2352x1568; 45° field of view — 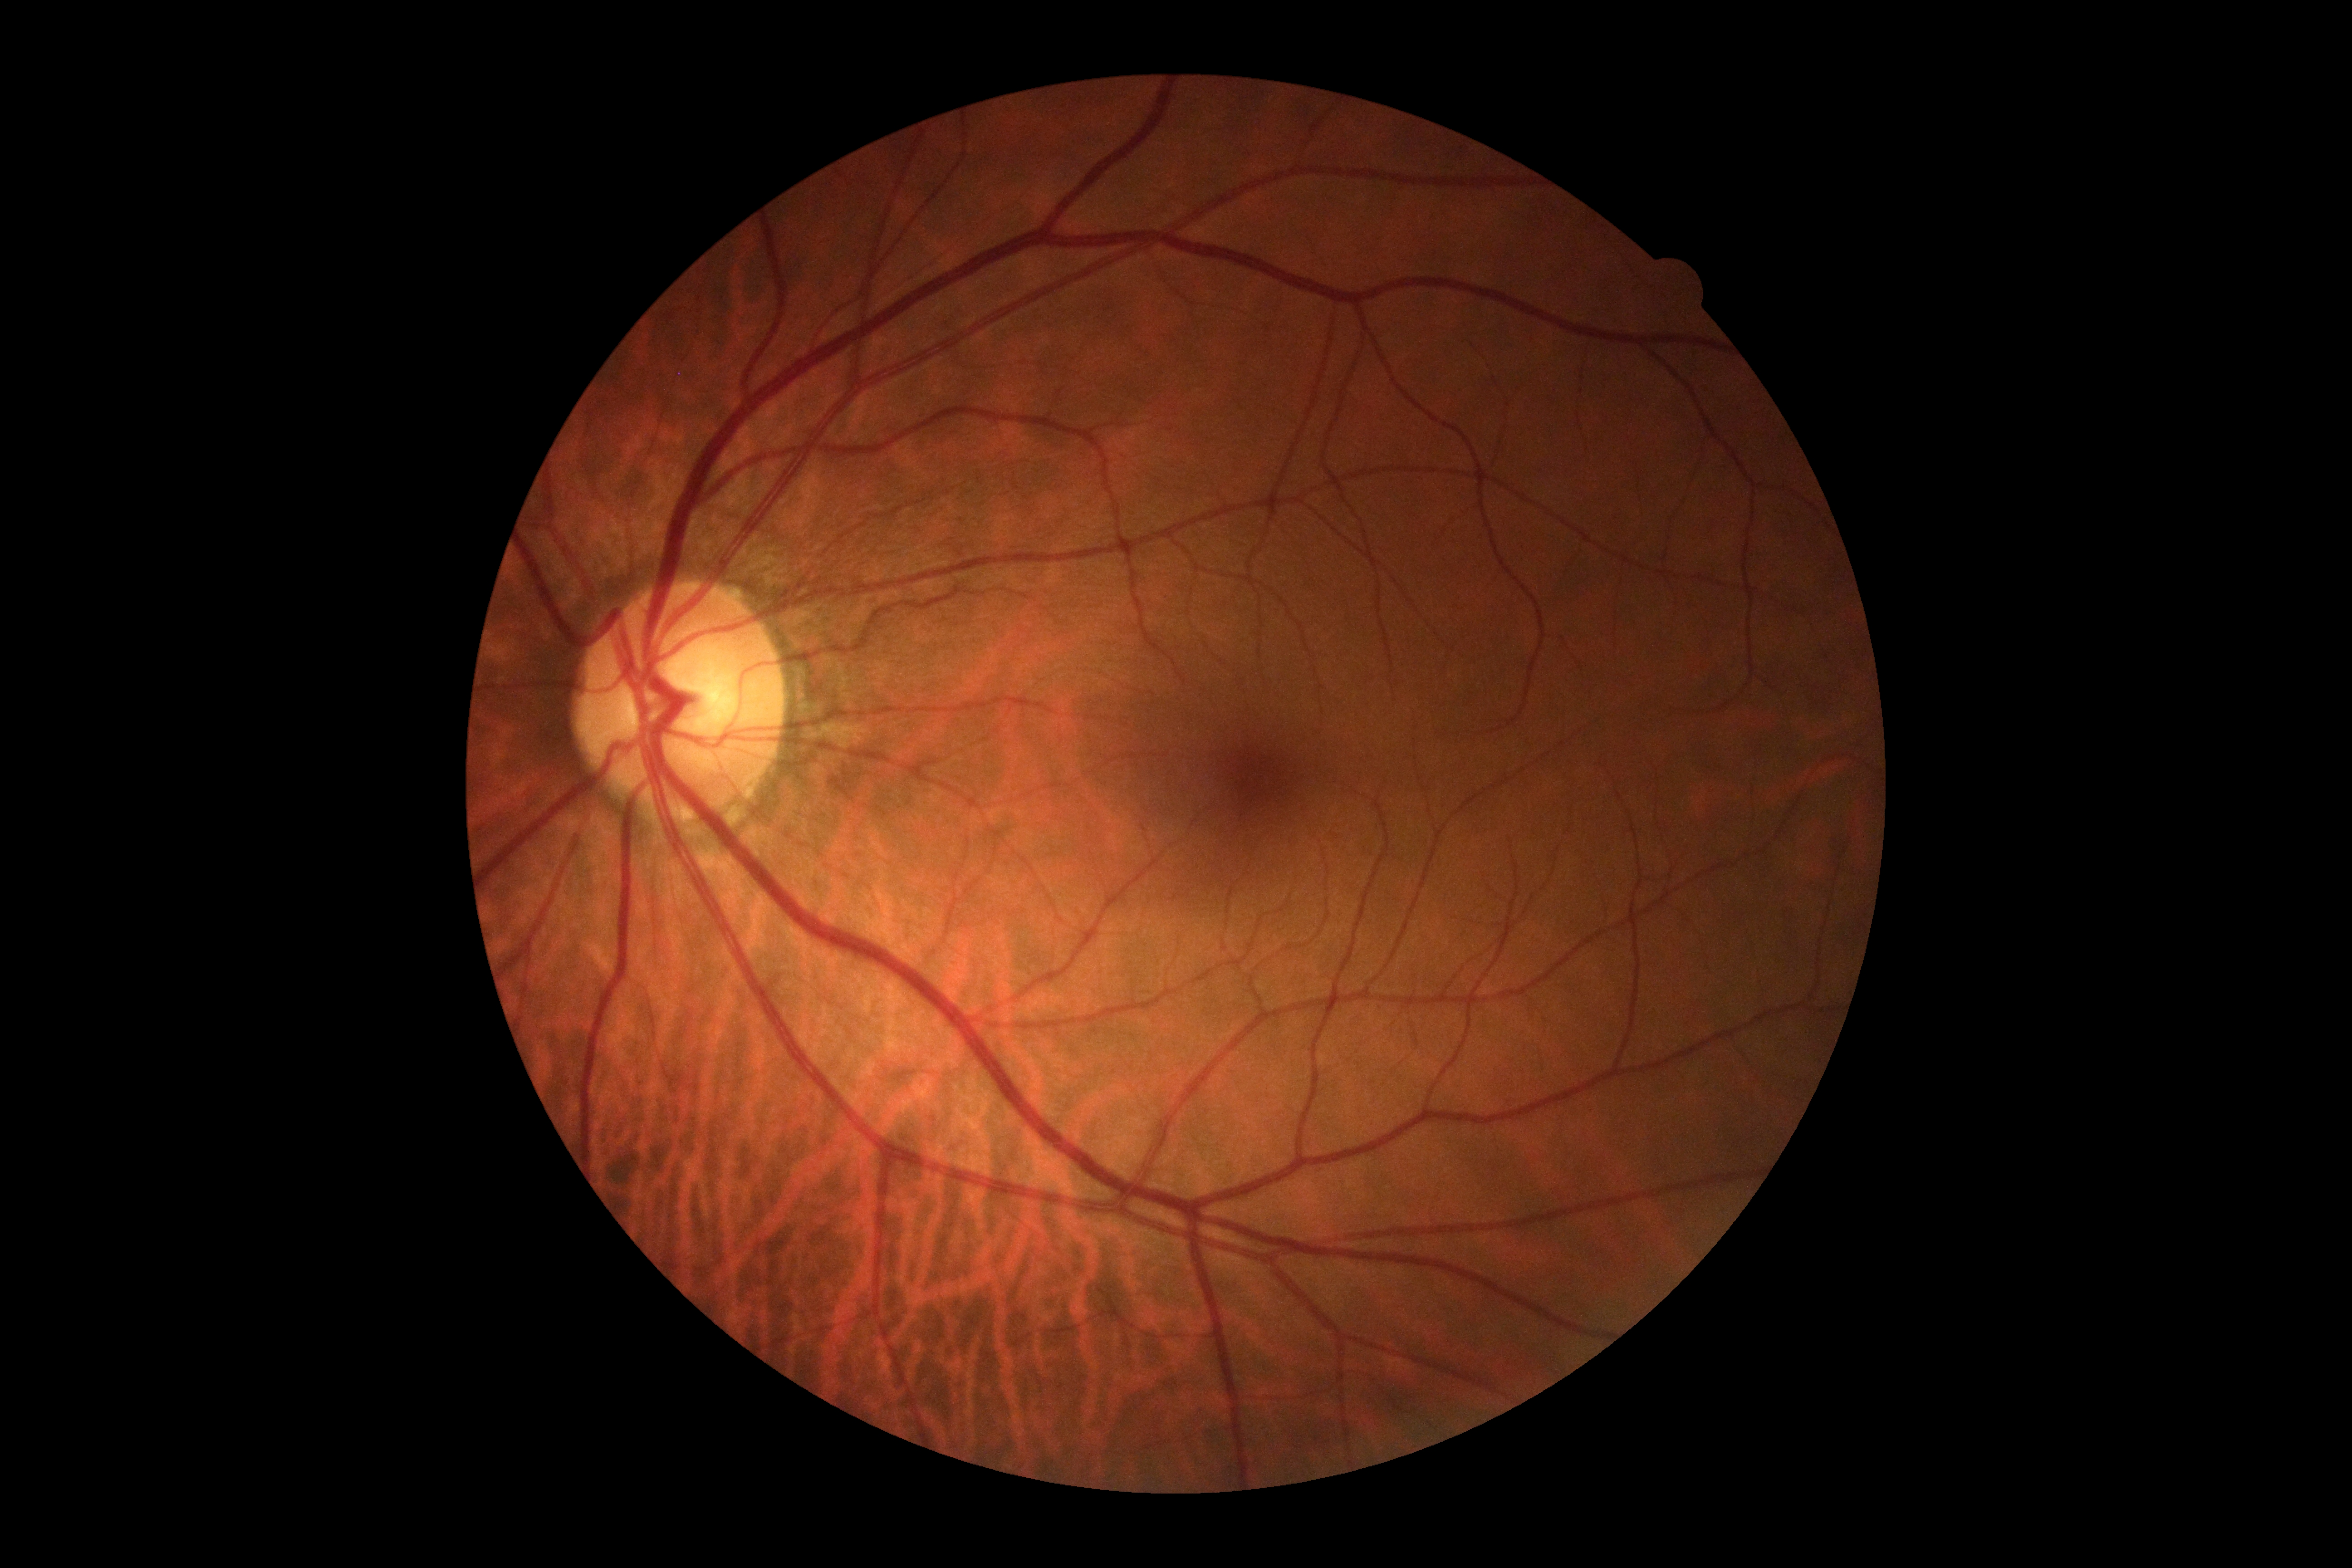
DR severity: grade 0 (no apparent retinopathy). No signs of diabetic retinopathy.